Posterior pole color fundus photograph, graded on the modified Davis scale — 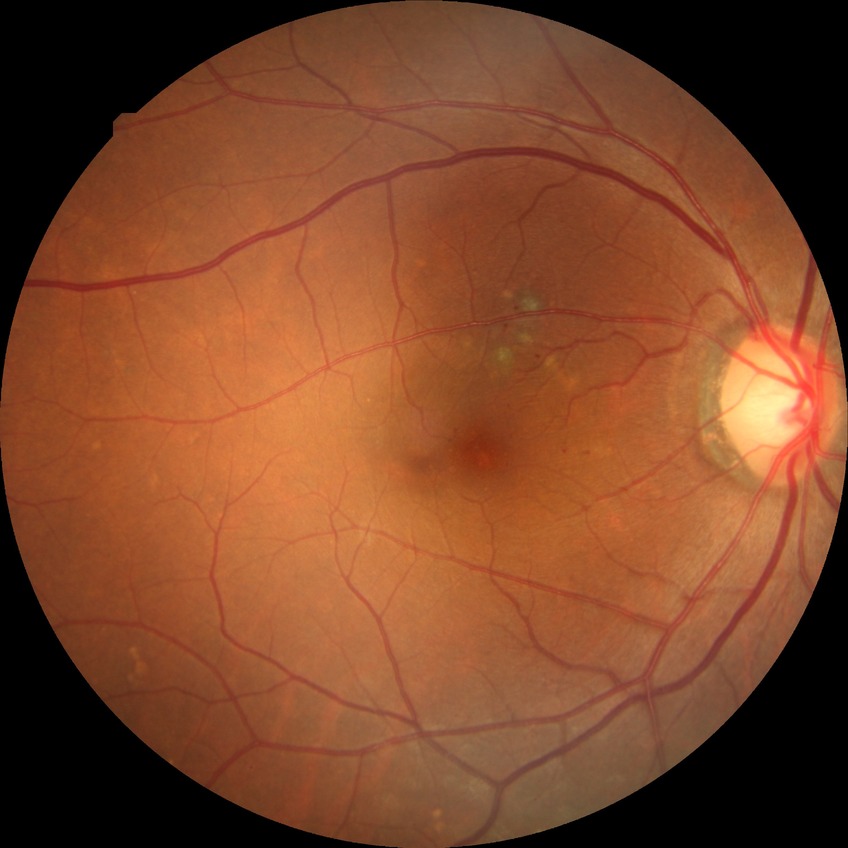
Diabetic retinopathy (DR) is SDR (simple diabetic retinopathy).